Pediatric wide-field fundus photograph.
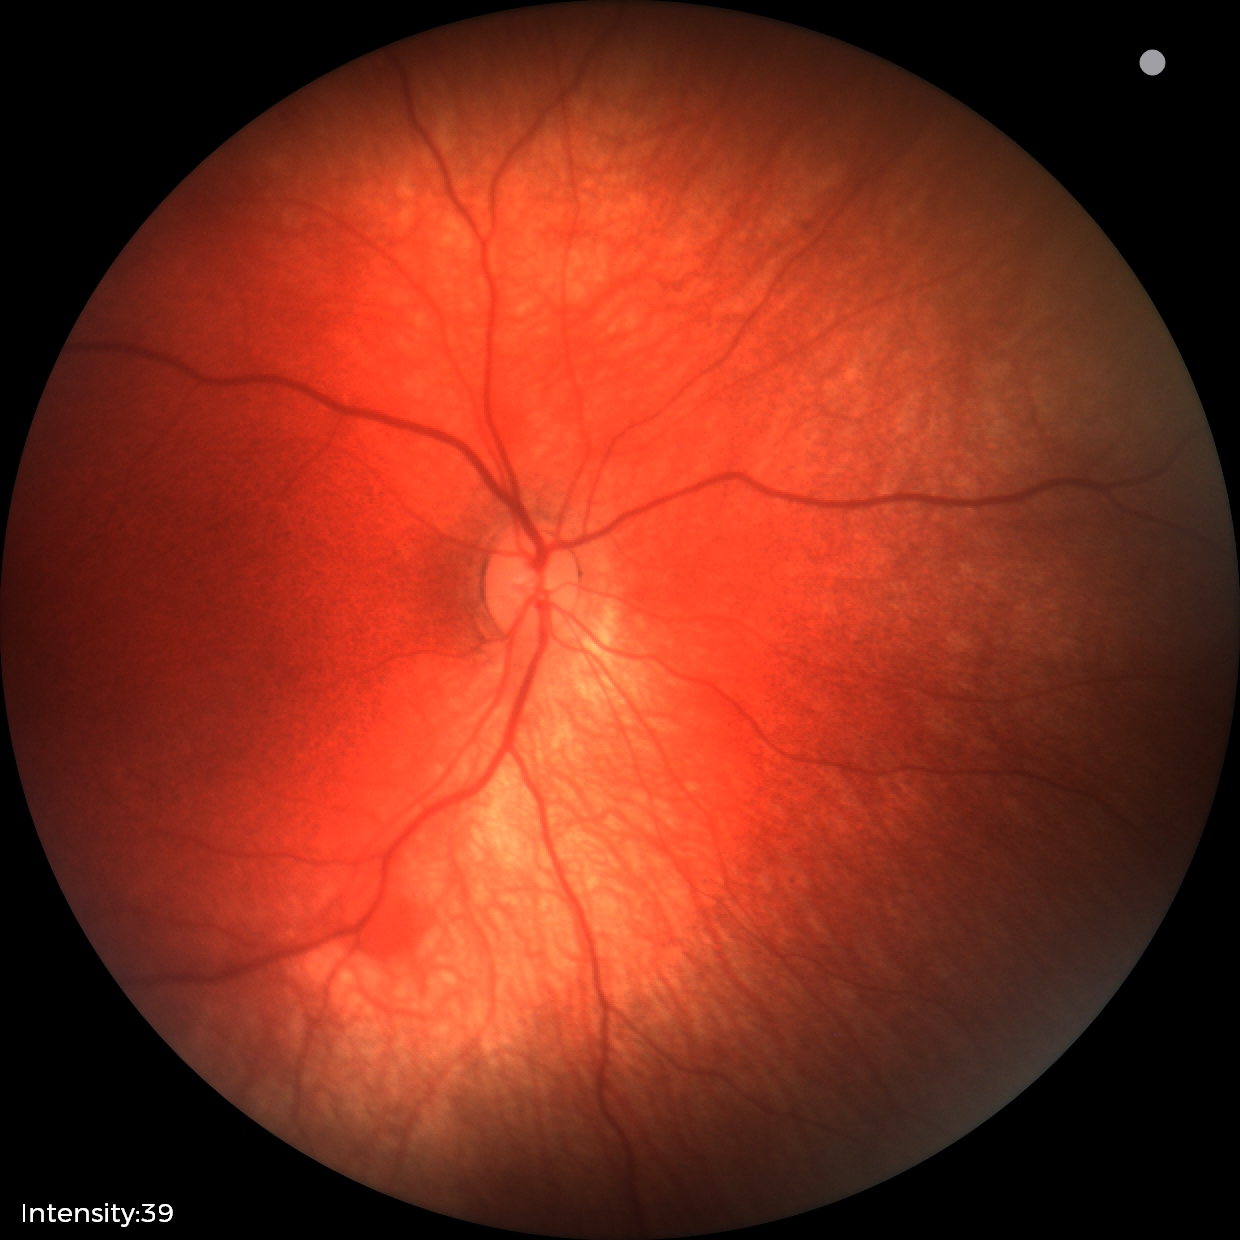

Screening diagnosis: retinal hemorrhages.